Modified Davis classification: 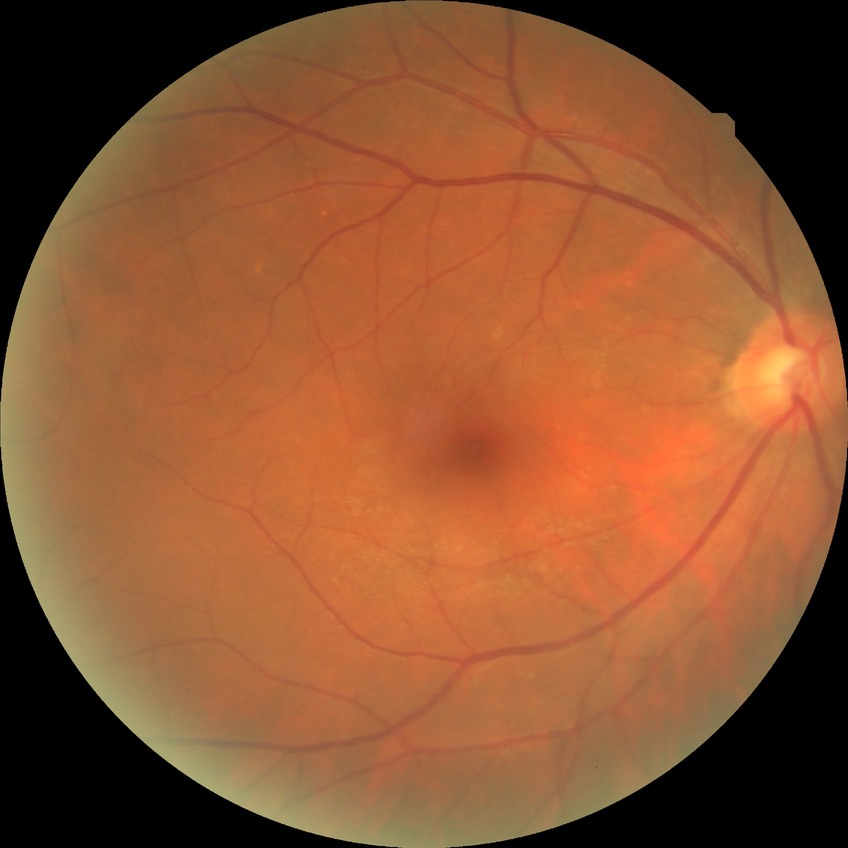 {
  "davis_grade": "no diabetic retinopathy"
}